Color fundus image, 2352 by 1568 pixels, 45-degree field of view.
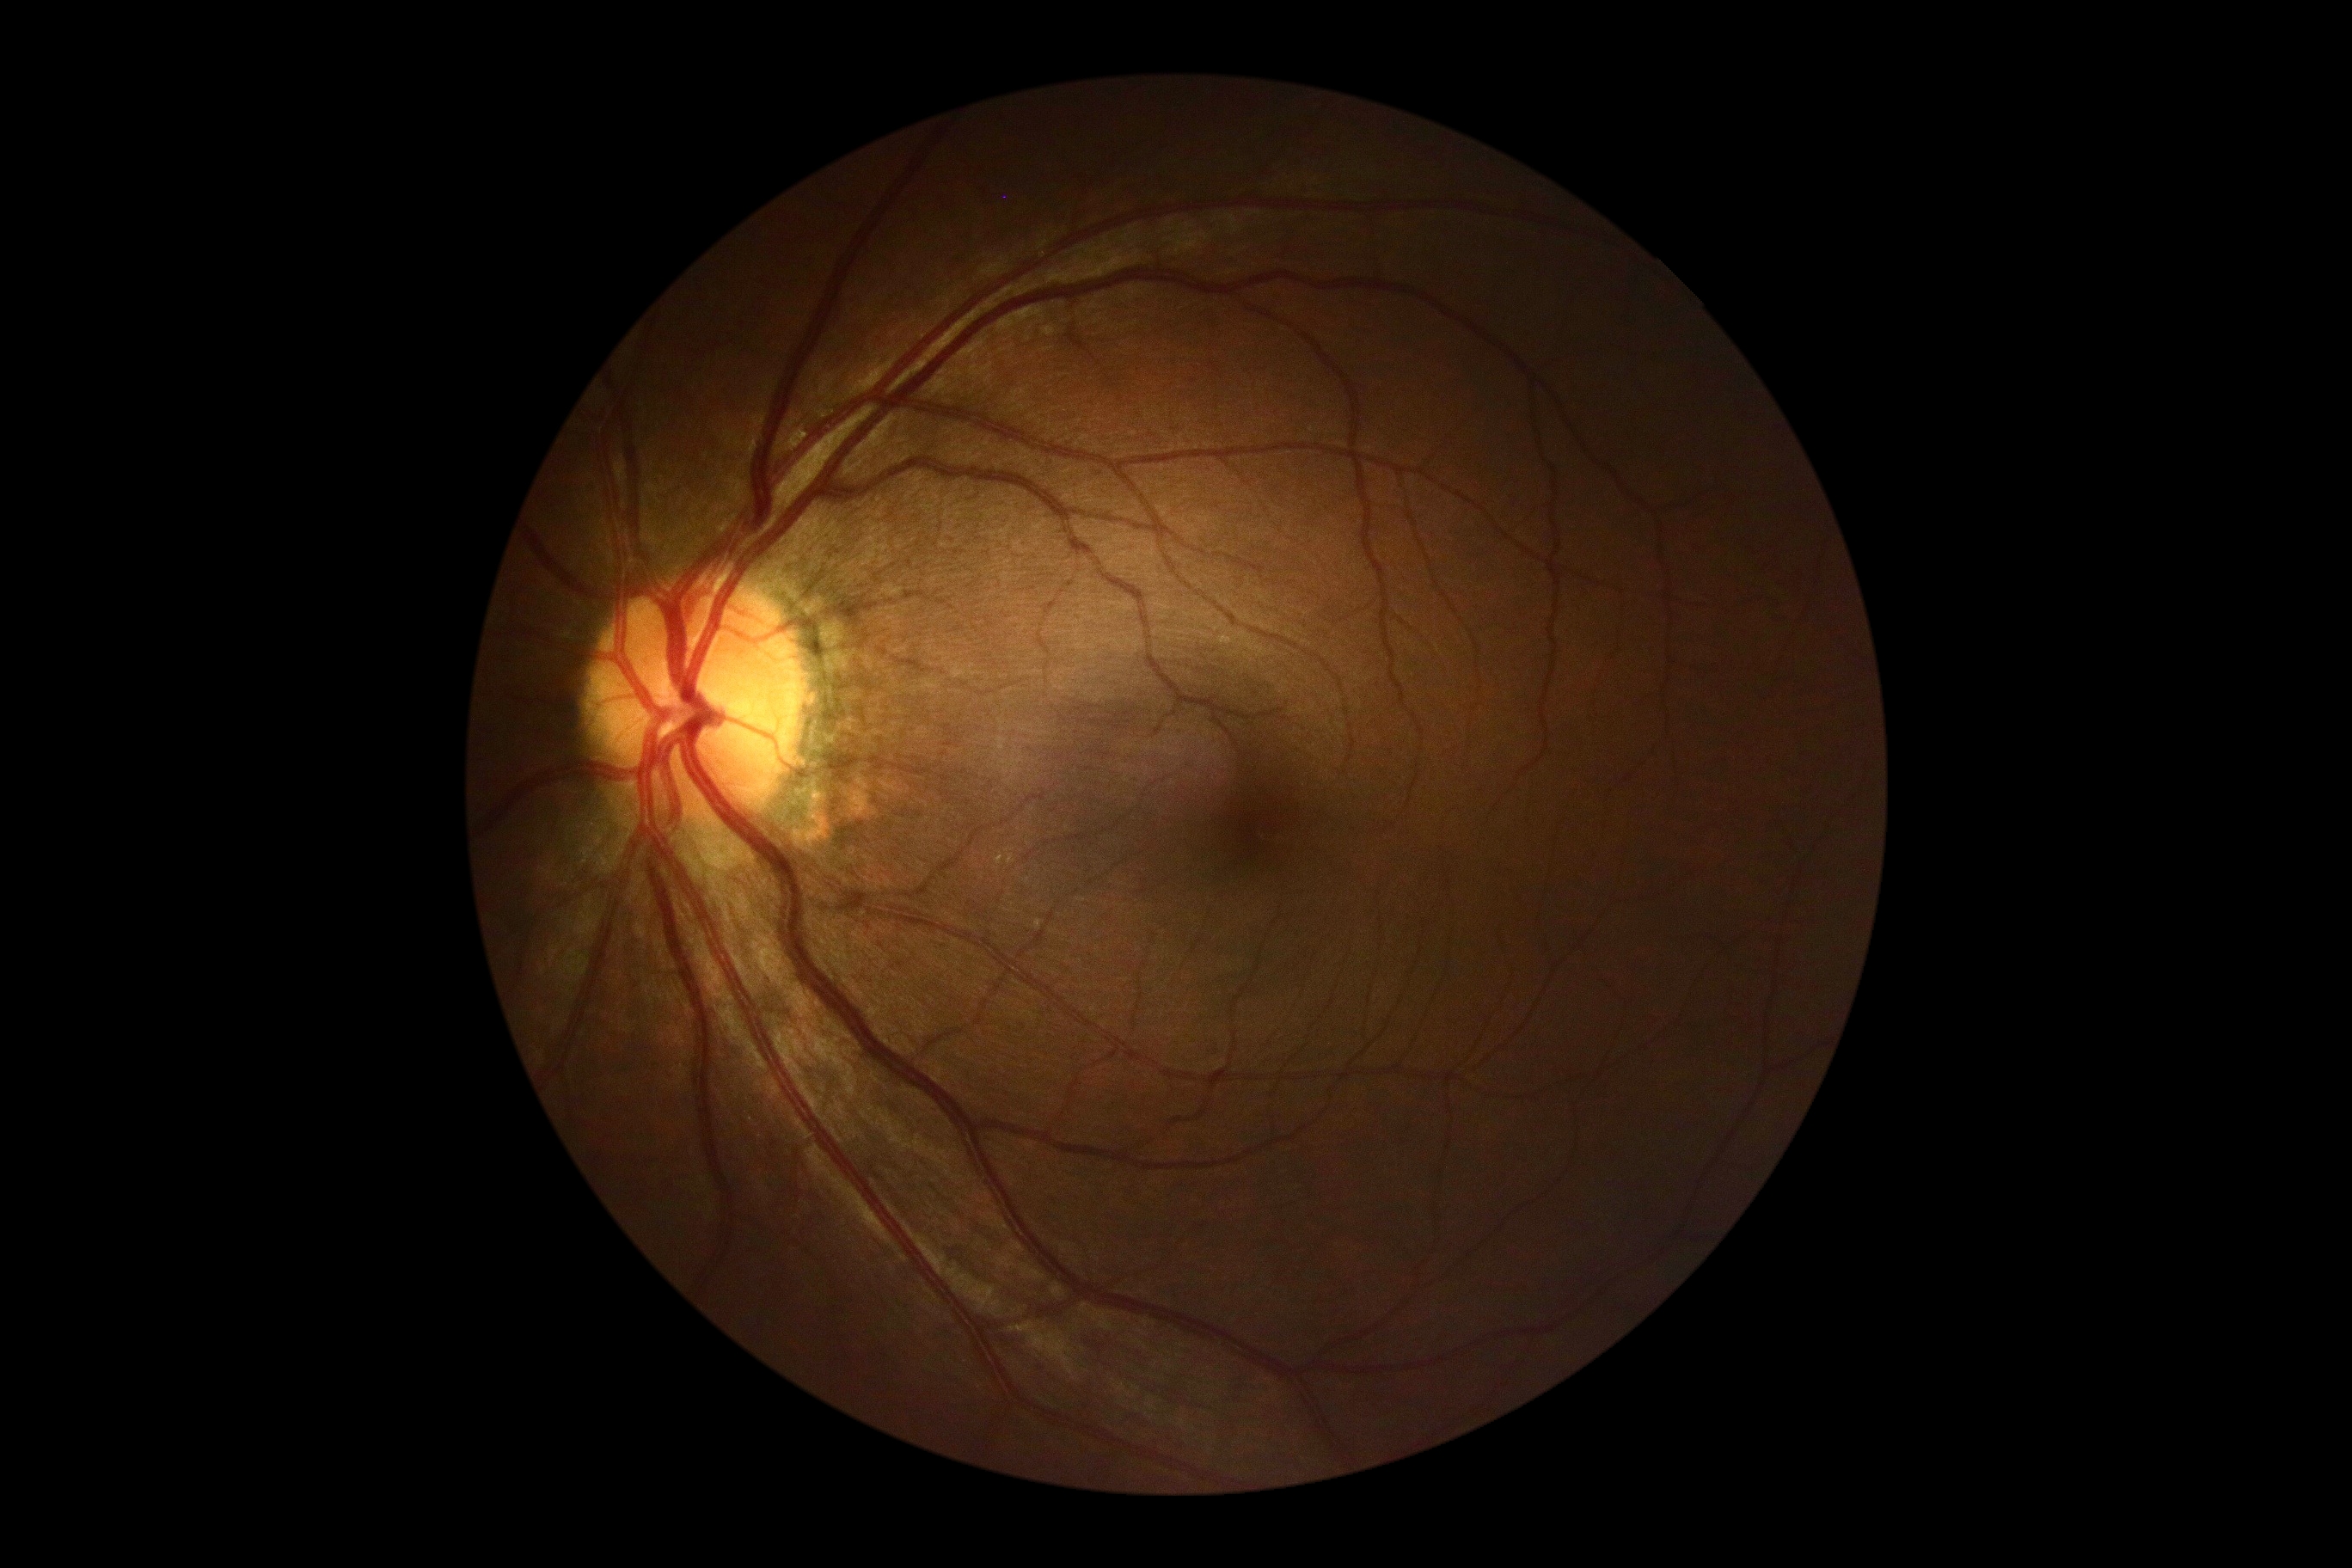

DR grade is 0.
No signs of diabetic retinopathy.